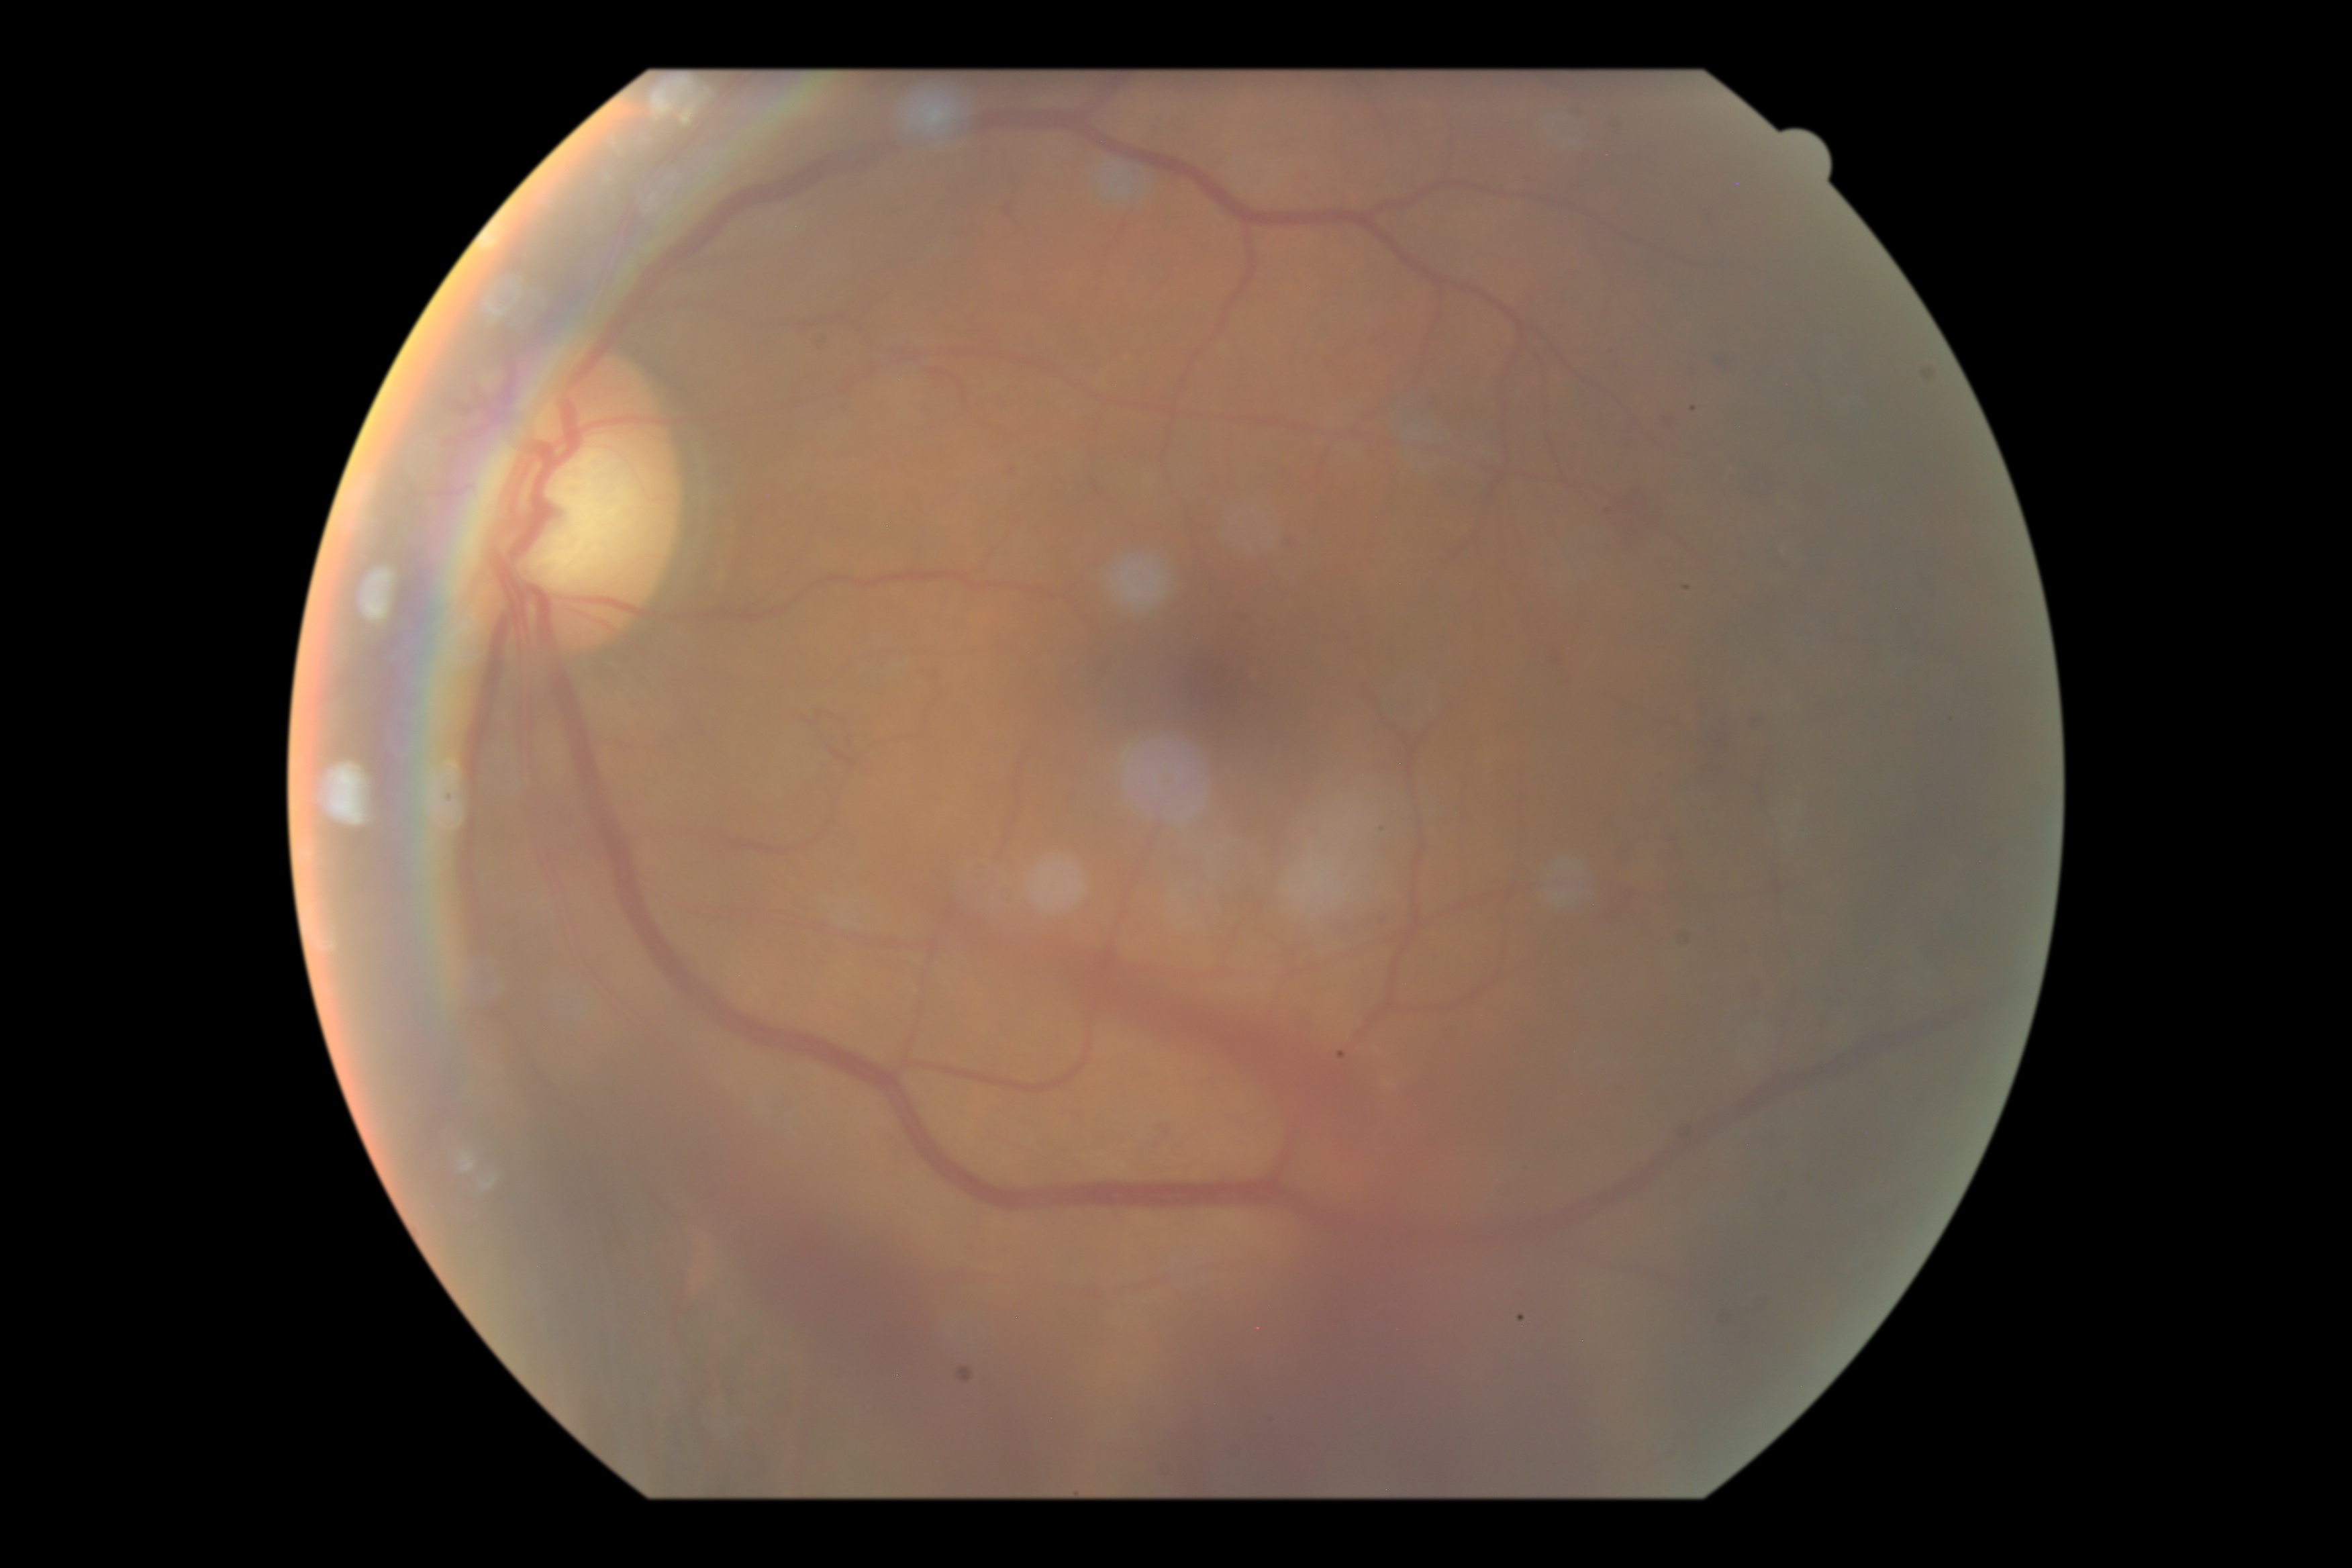
{"dr_grade": "4"}